45-degree field of view. 1380 x 1382 pixels. CFP: 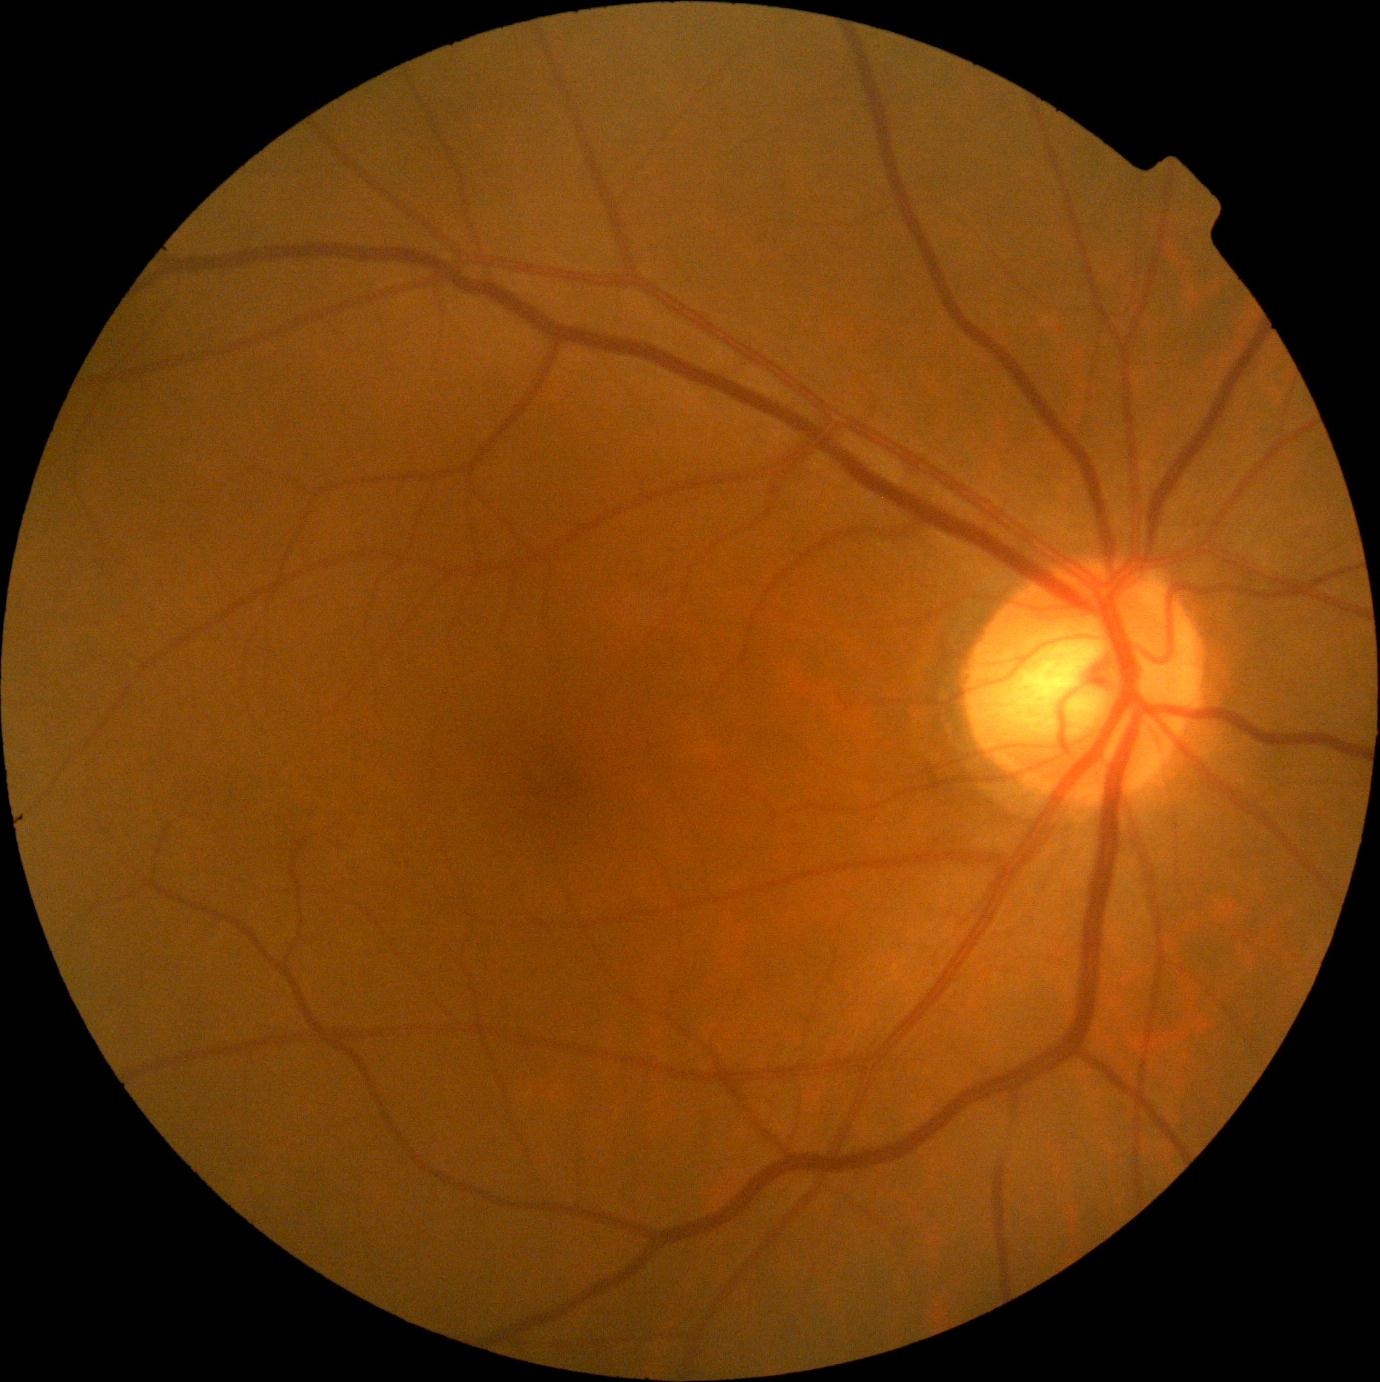
{
  "dr_impression": "no DR findings",
  "dr_grade": "no apparent diabetic retinopathy (grade 0)"
}